Fundus photo, image size 848x848, nonmydriatic fundus photograph — 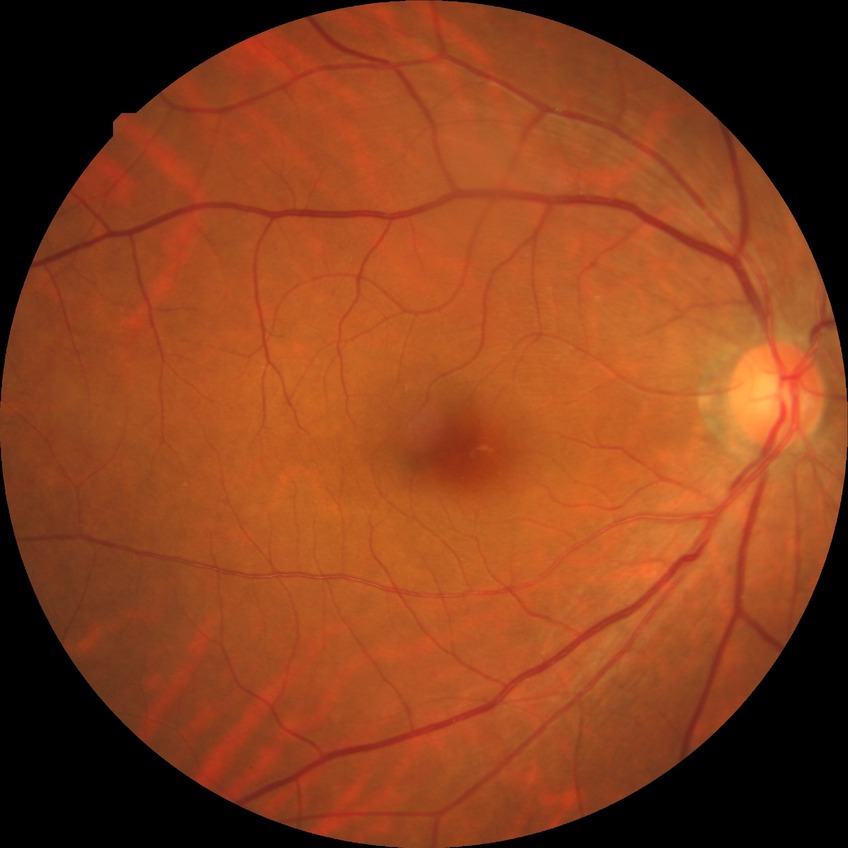
diabetic retinopathy grade = simple diabetic retinopathy; DR class = non-proliferative diabetic retinopathy.